FOV: 45 degrees.
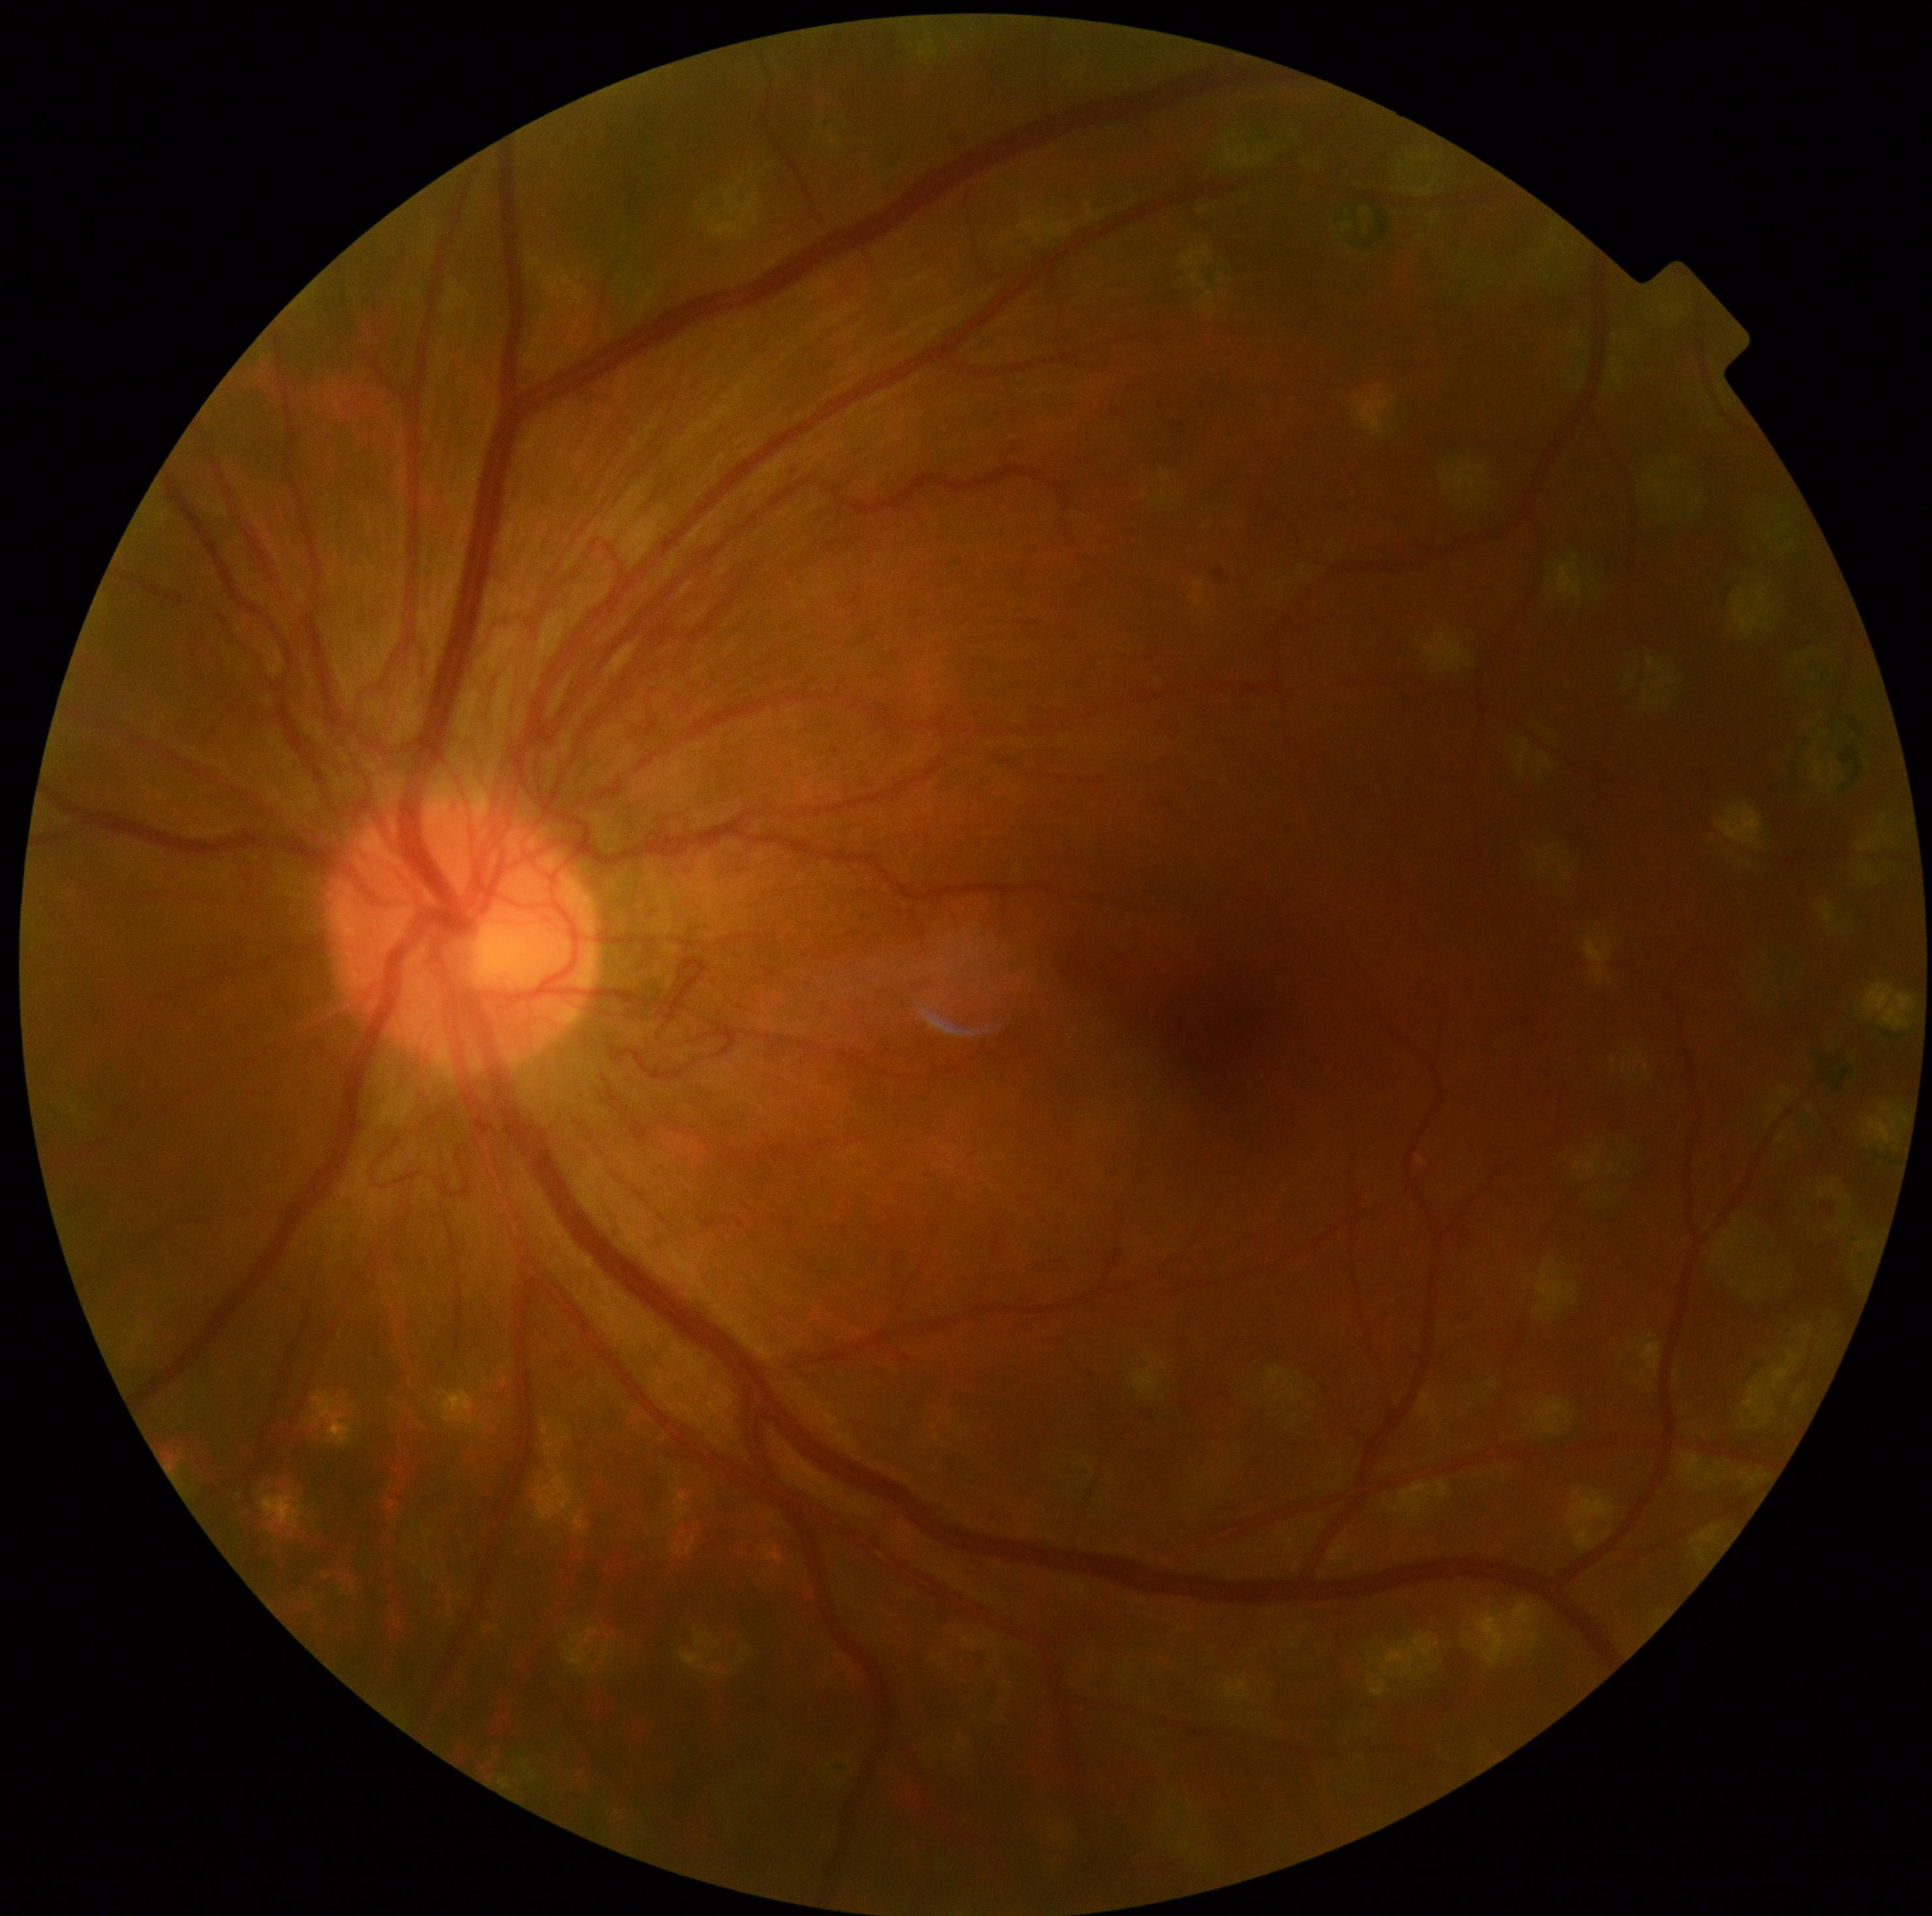
DR stage: 4/4.